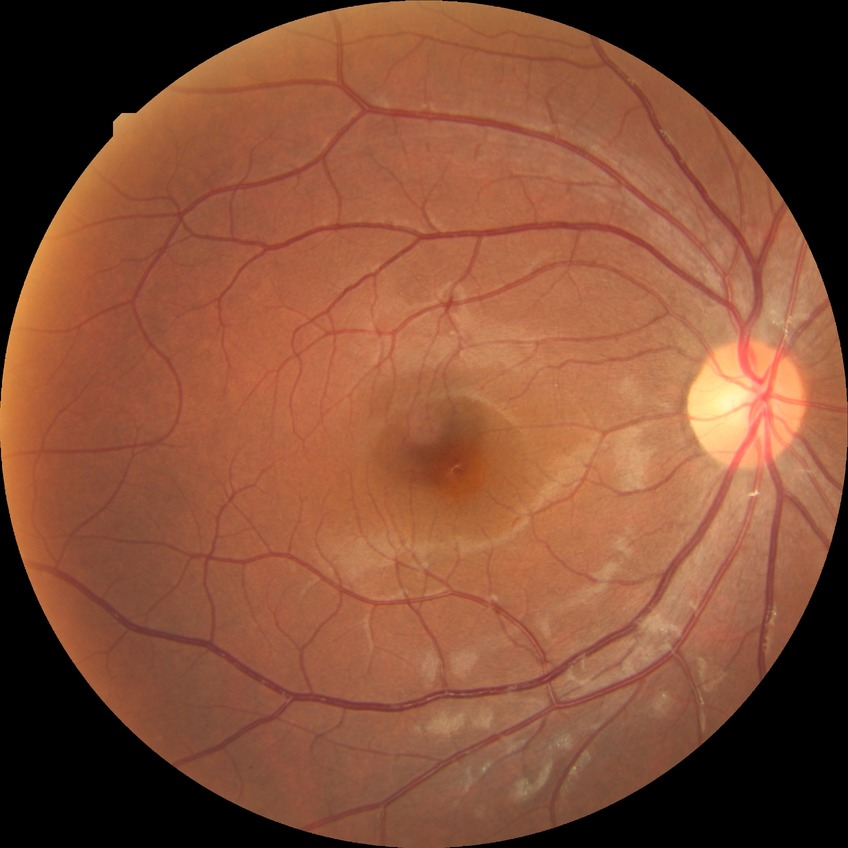

  davis_grade: no diabetic retinopathy (NDR)